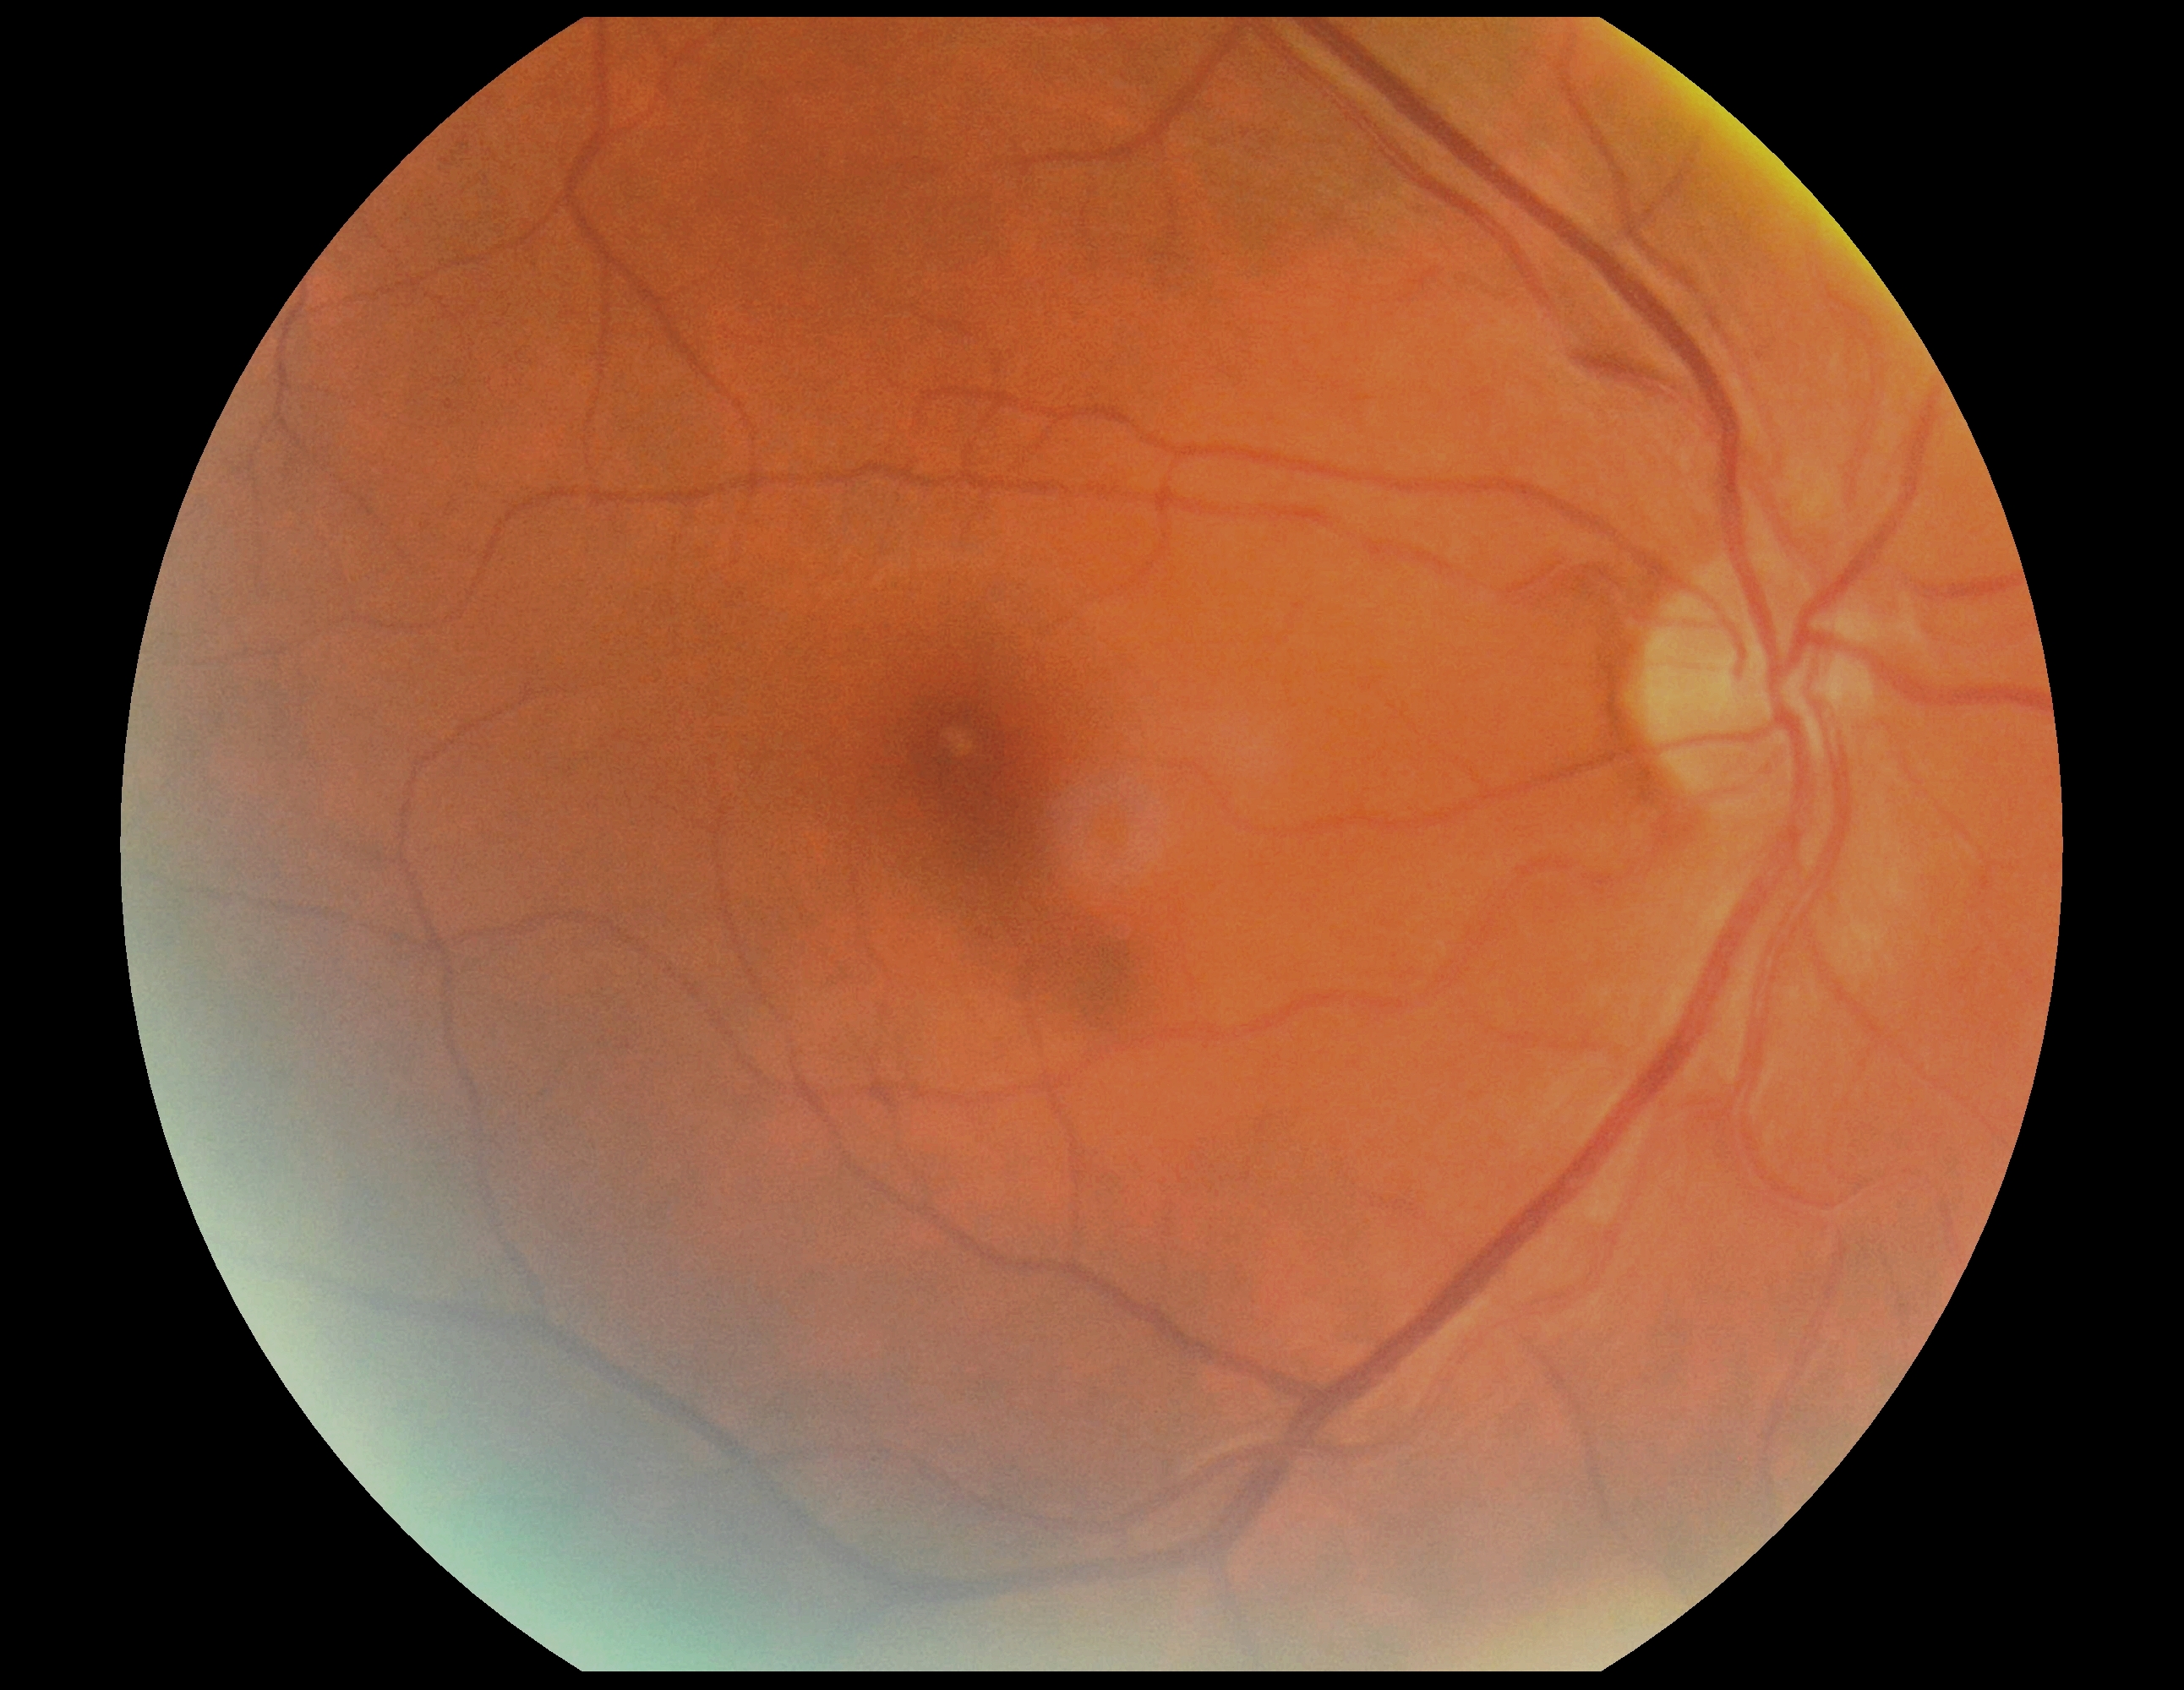
Retinopathy grade: 0.